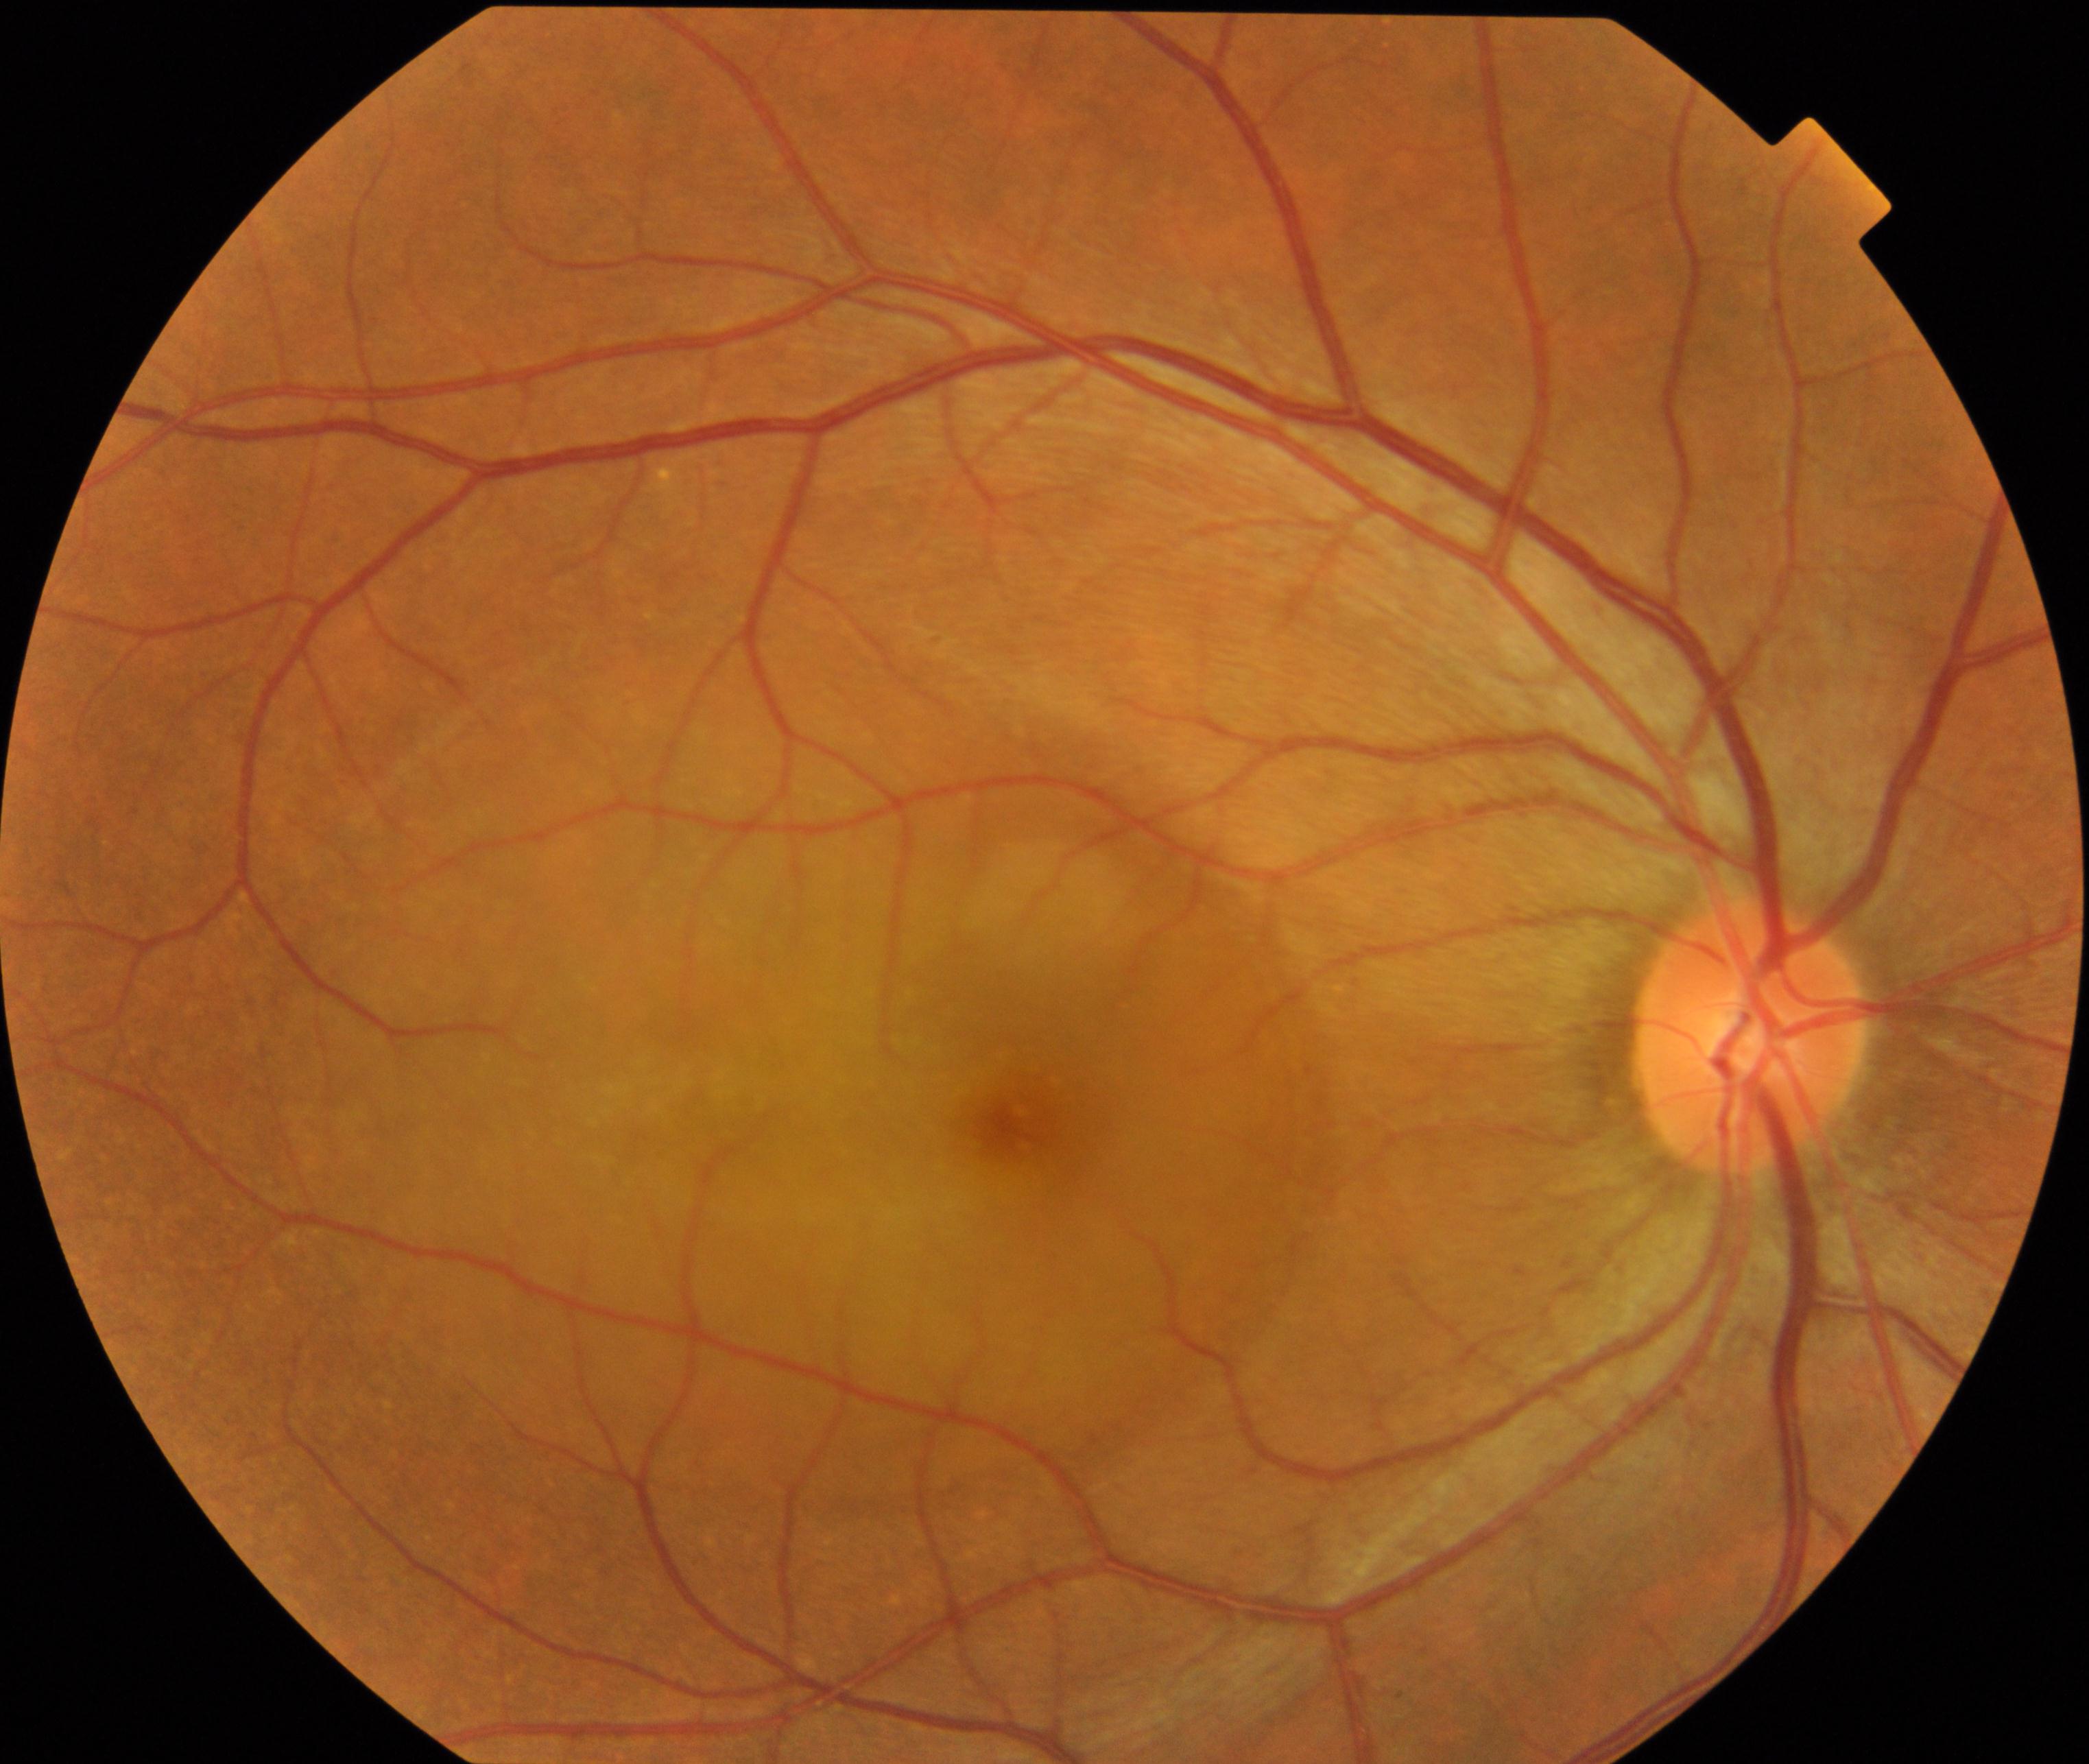 This fundus photograph shows central serous chorioretinopathy.